CFP; image size 1536x1152; 45° FOV: 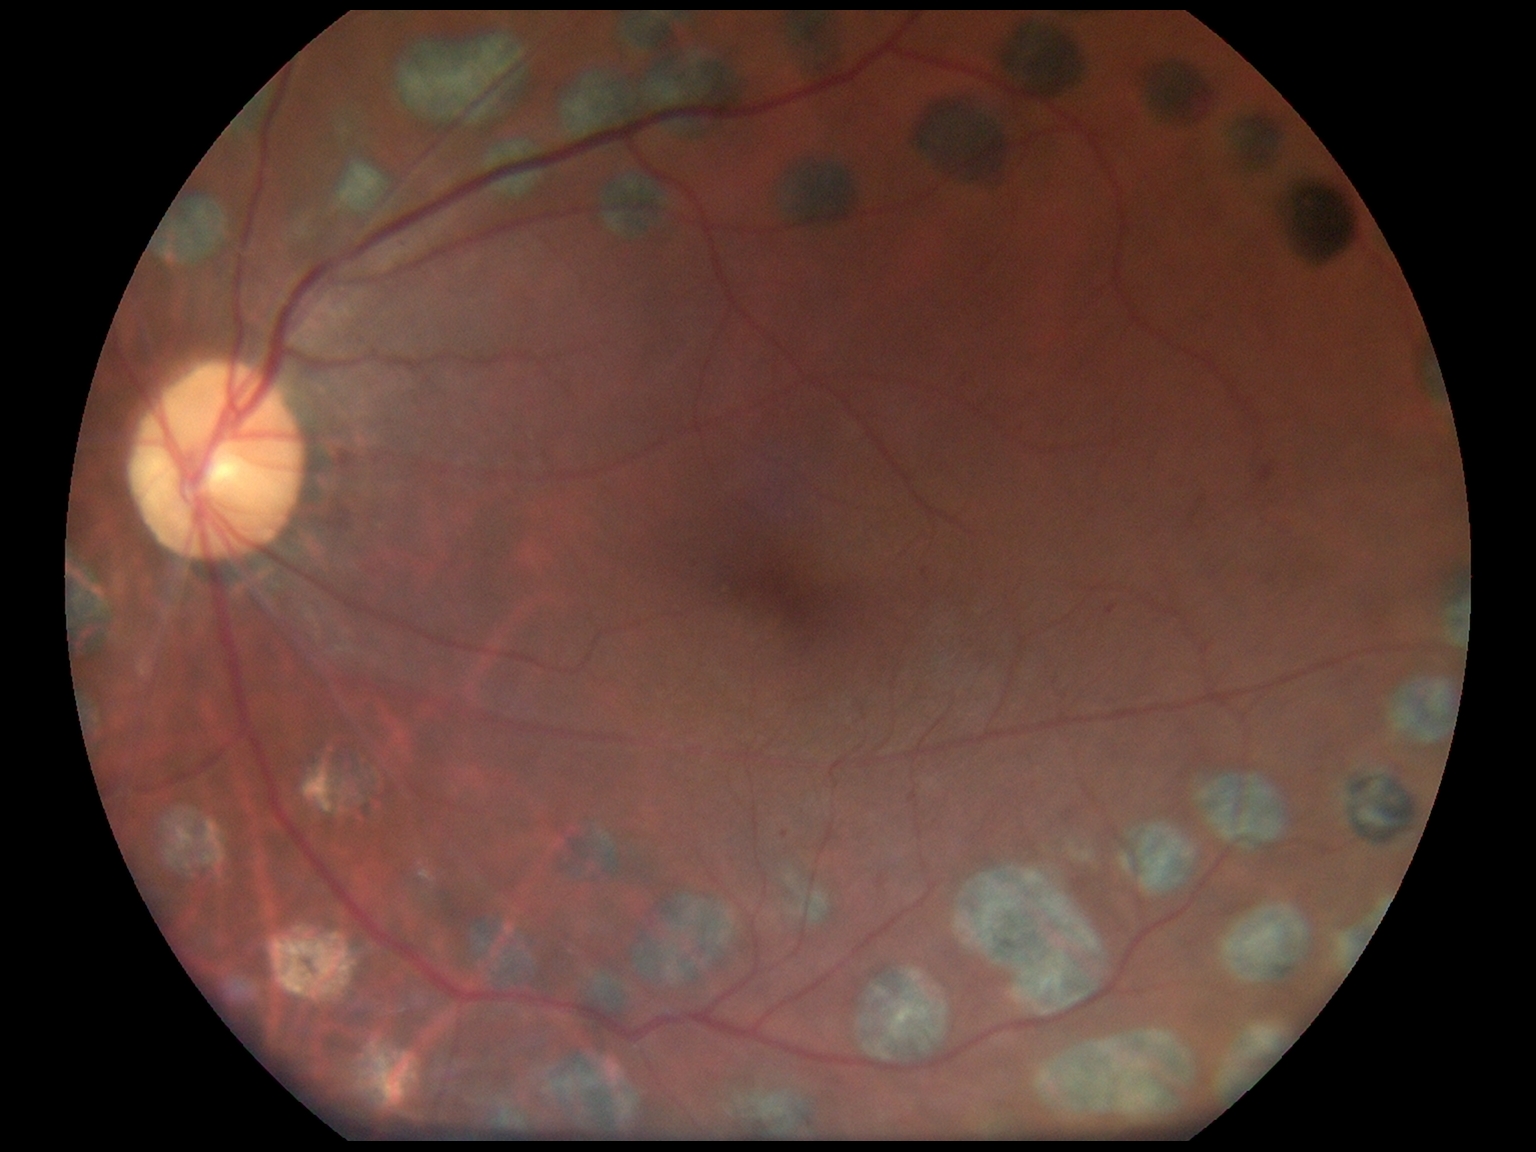
DR severity is grade 2 (moderate NPDR) — more than just microaneurysms but less than severe NPDR.